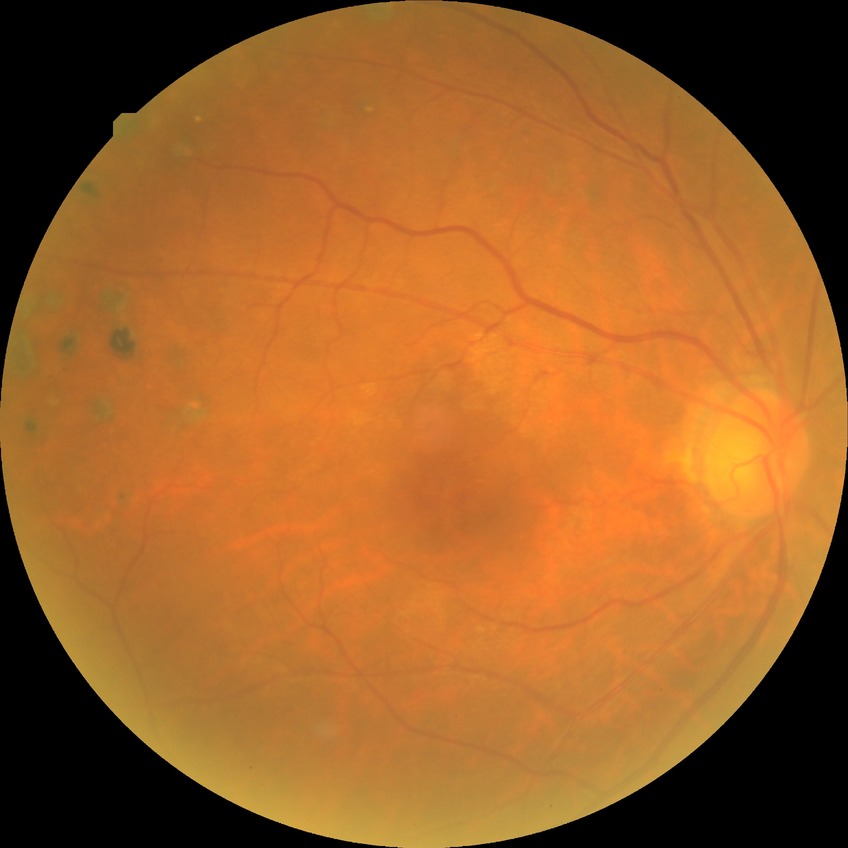 Annotations:
- diabetic retinopathy stage — proliferative diabetic retinopathy